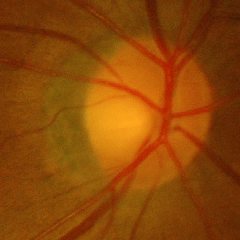 Assessment: no evidence of glaucoma.